Without pupil dilation. 848 by 848 pixels
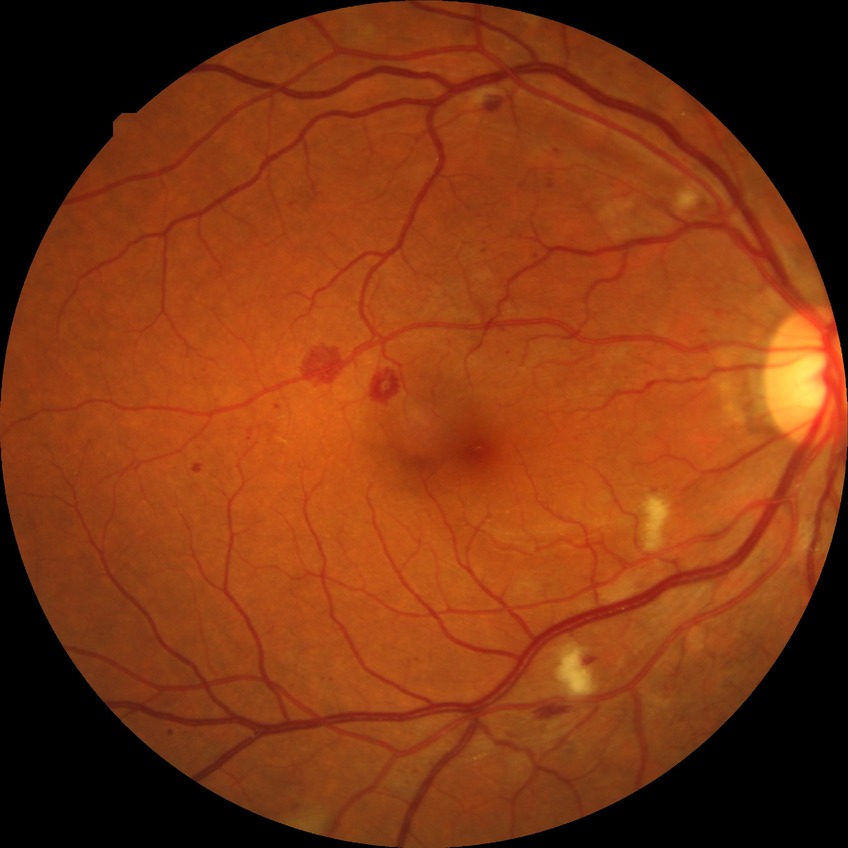
Davis grade: PPDR.